1659 by 2212 pixels.
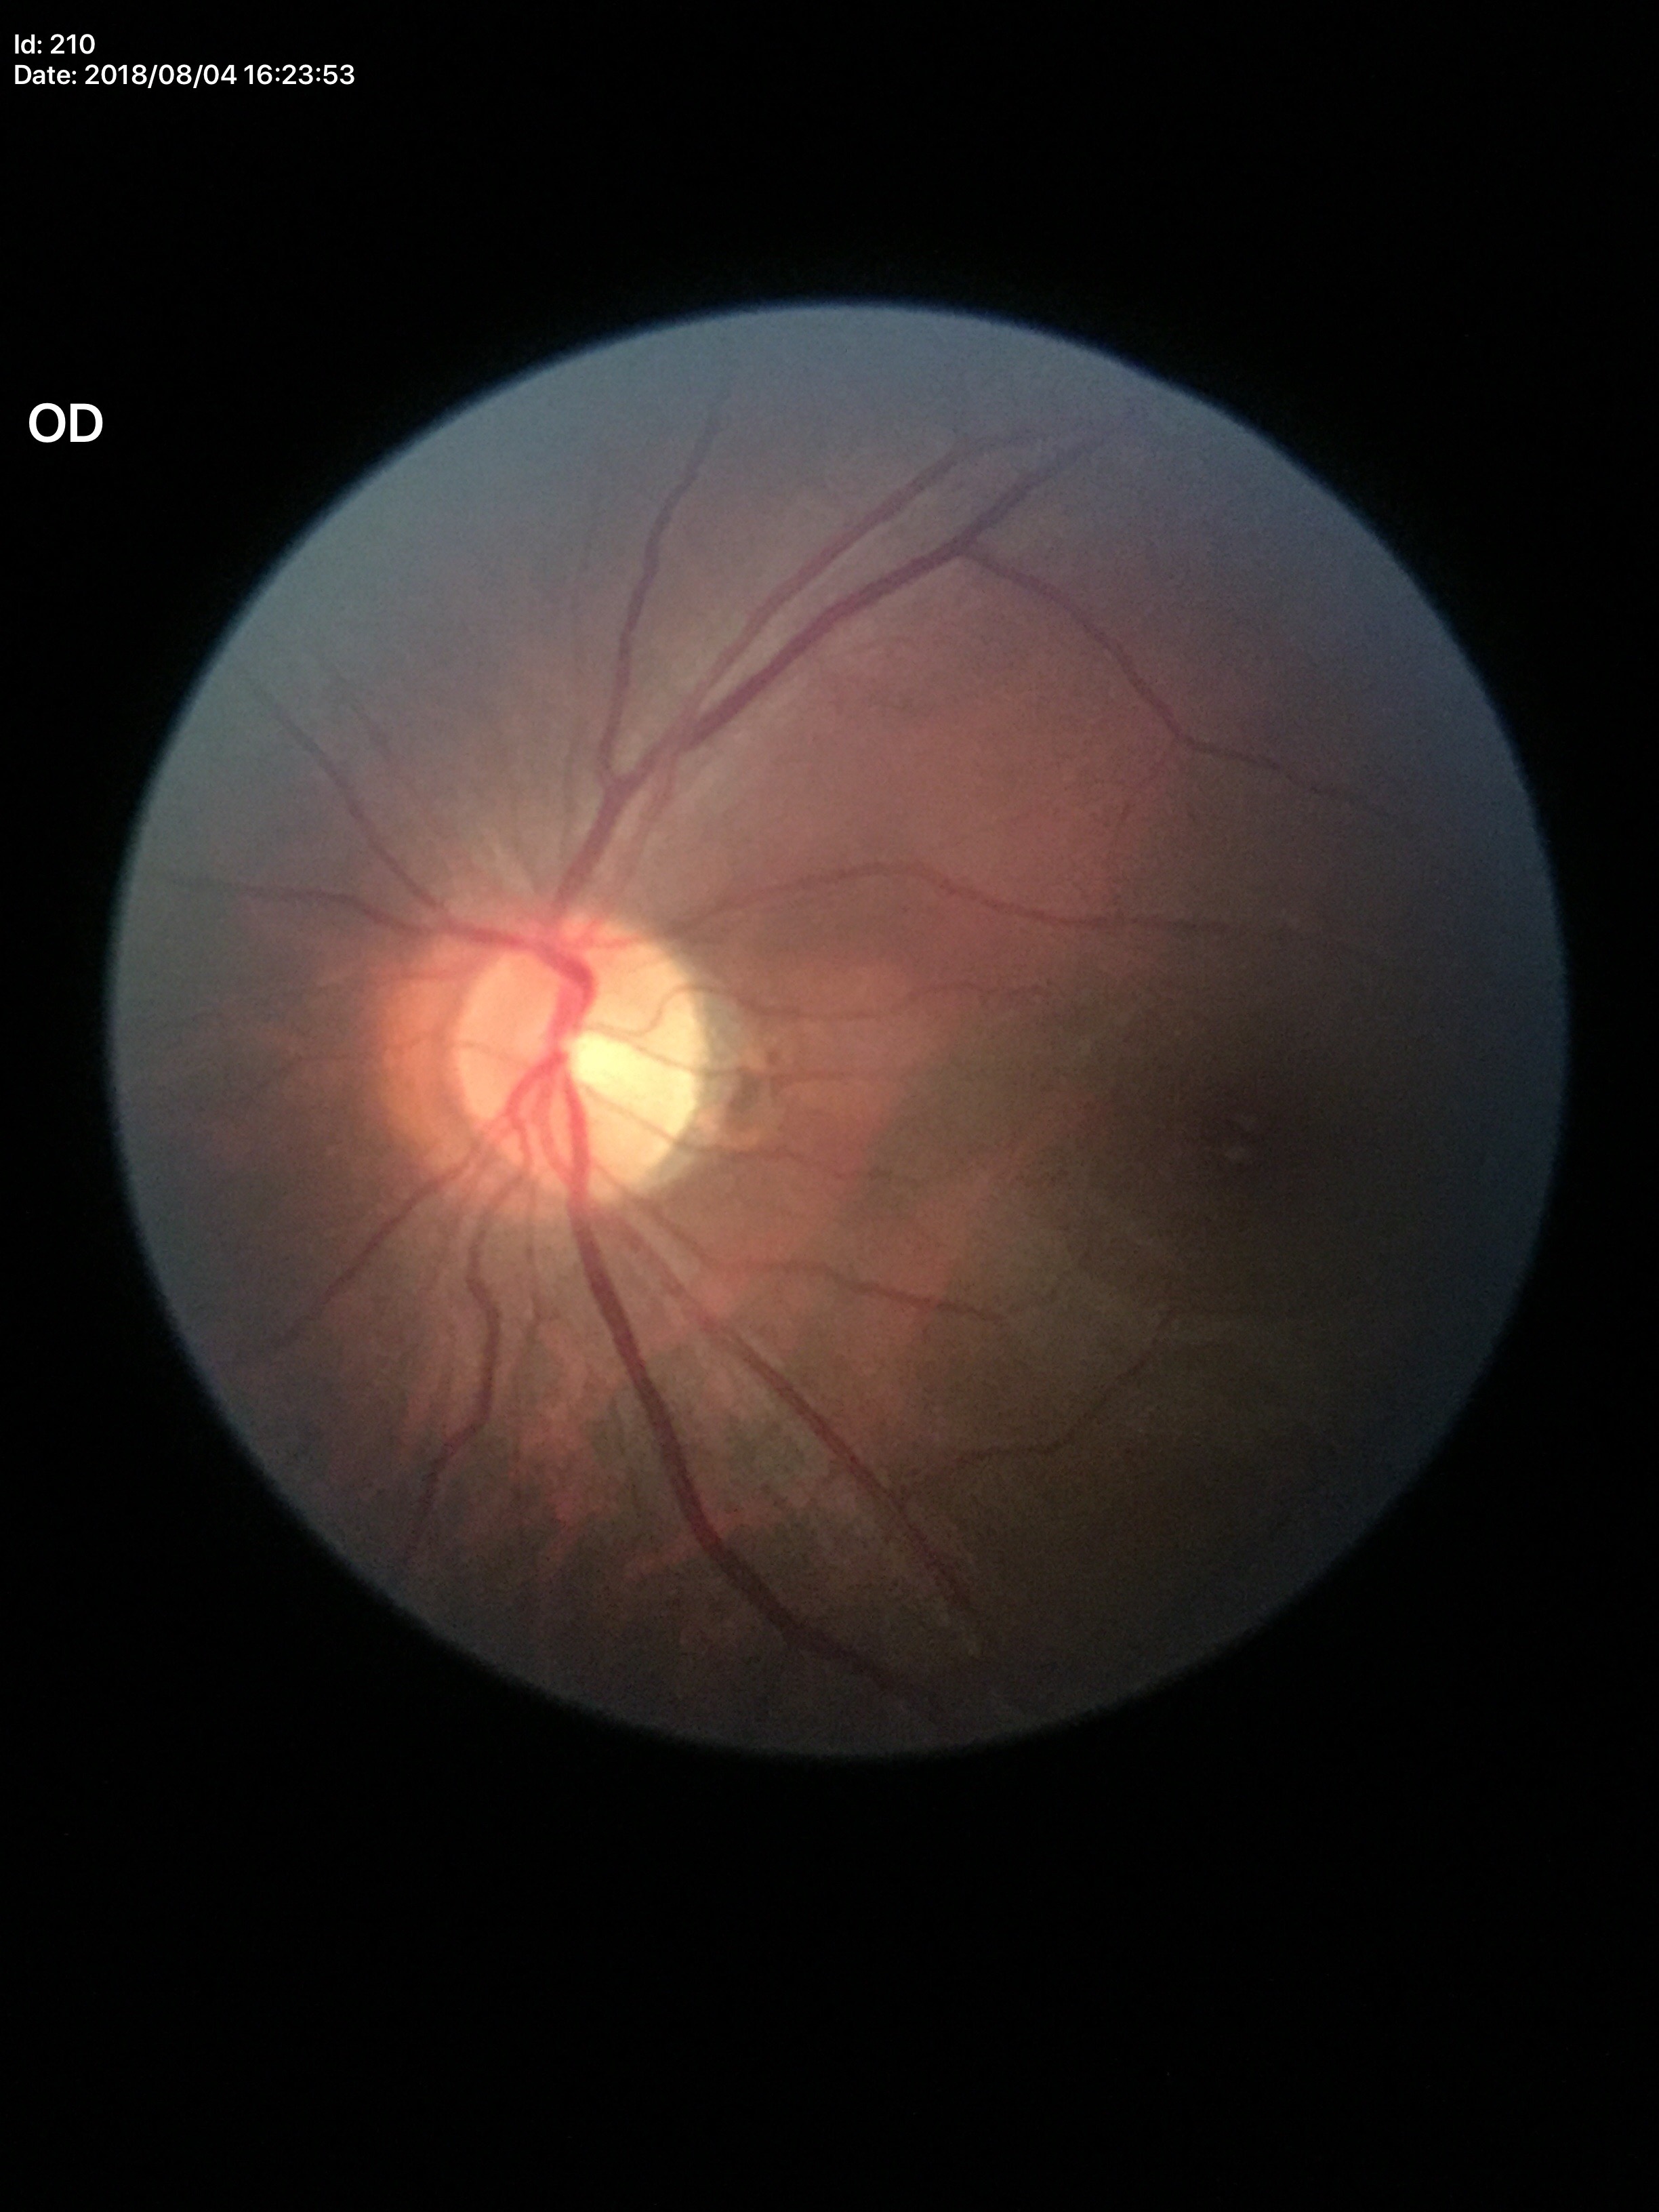 No evidence of glaucoma. Vertical cup-disc ratio: 0.53.